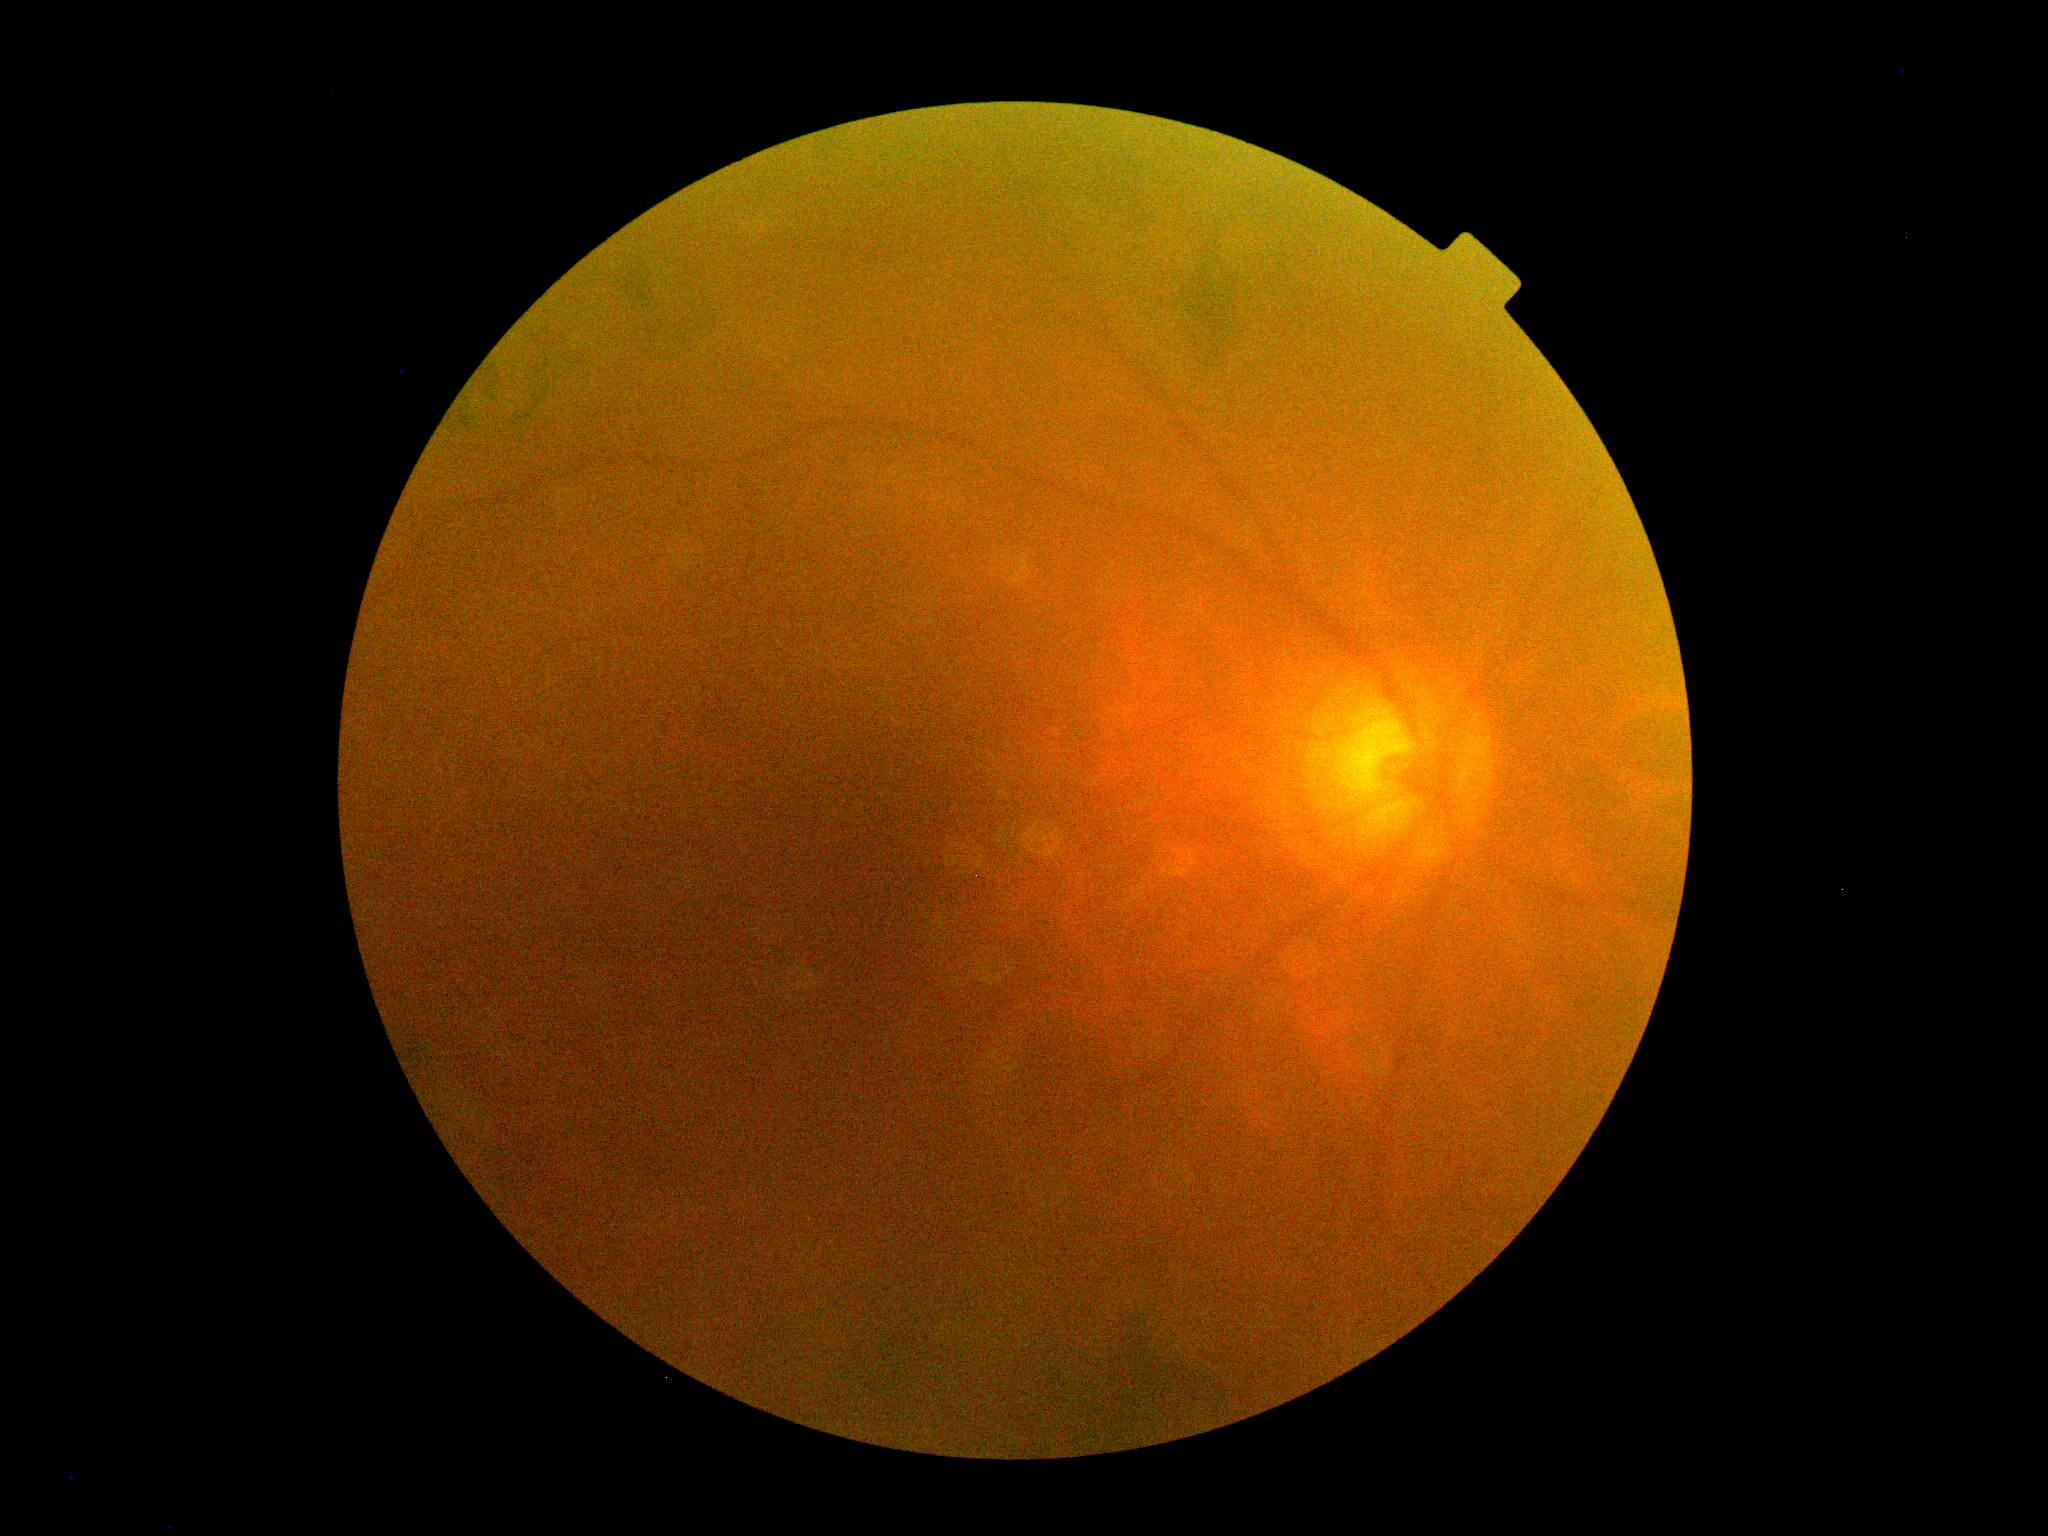 DR severity: grade 2 (moderate NPDR)